1659x2212px; CFP
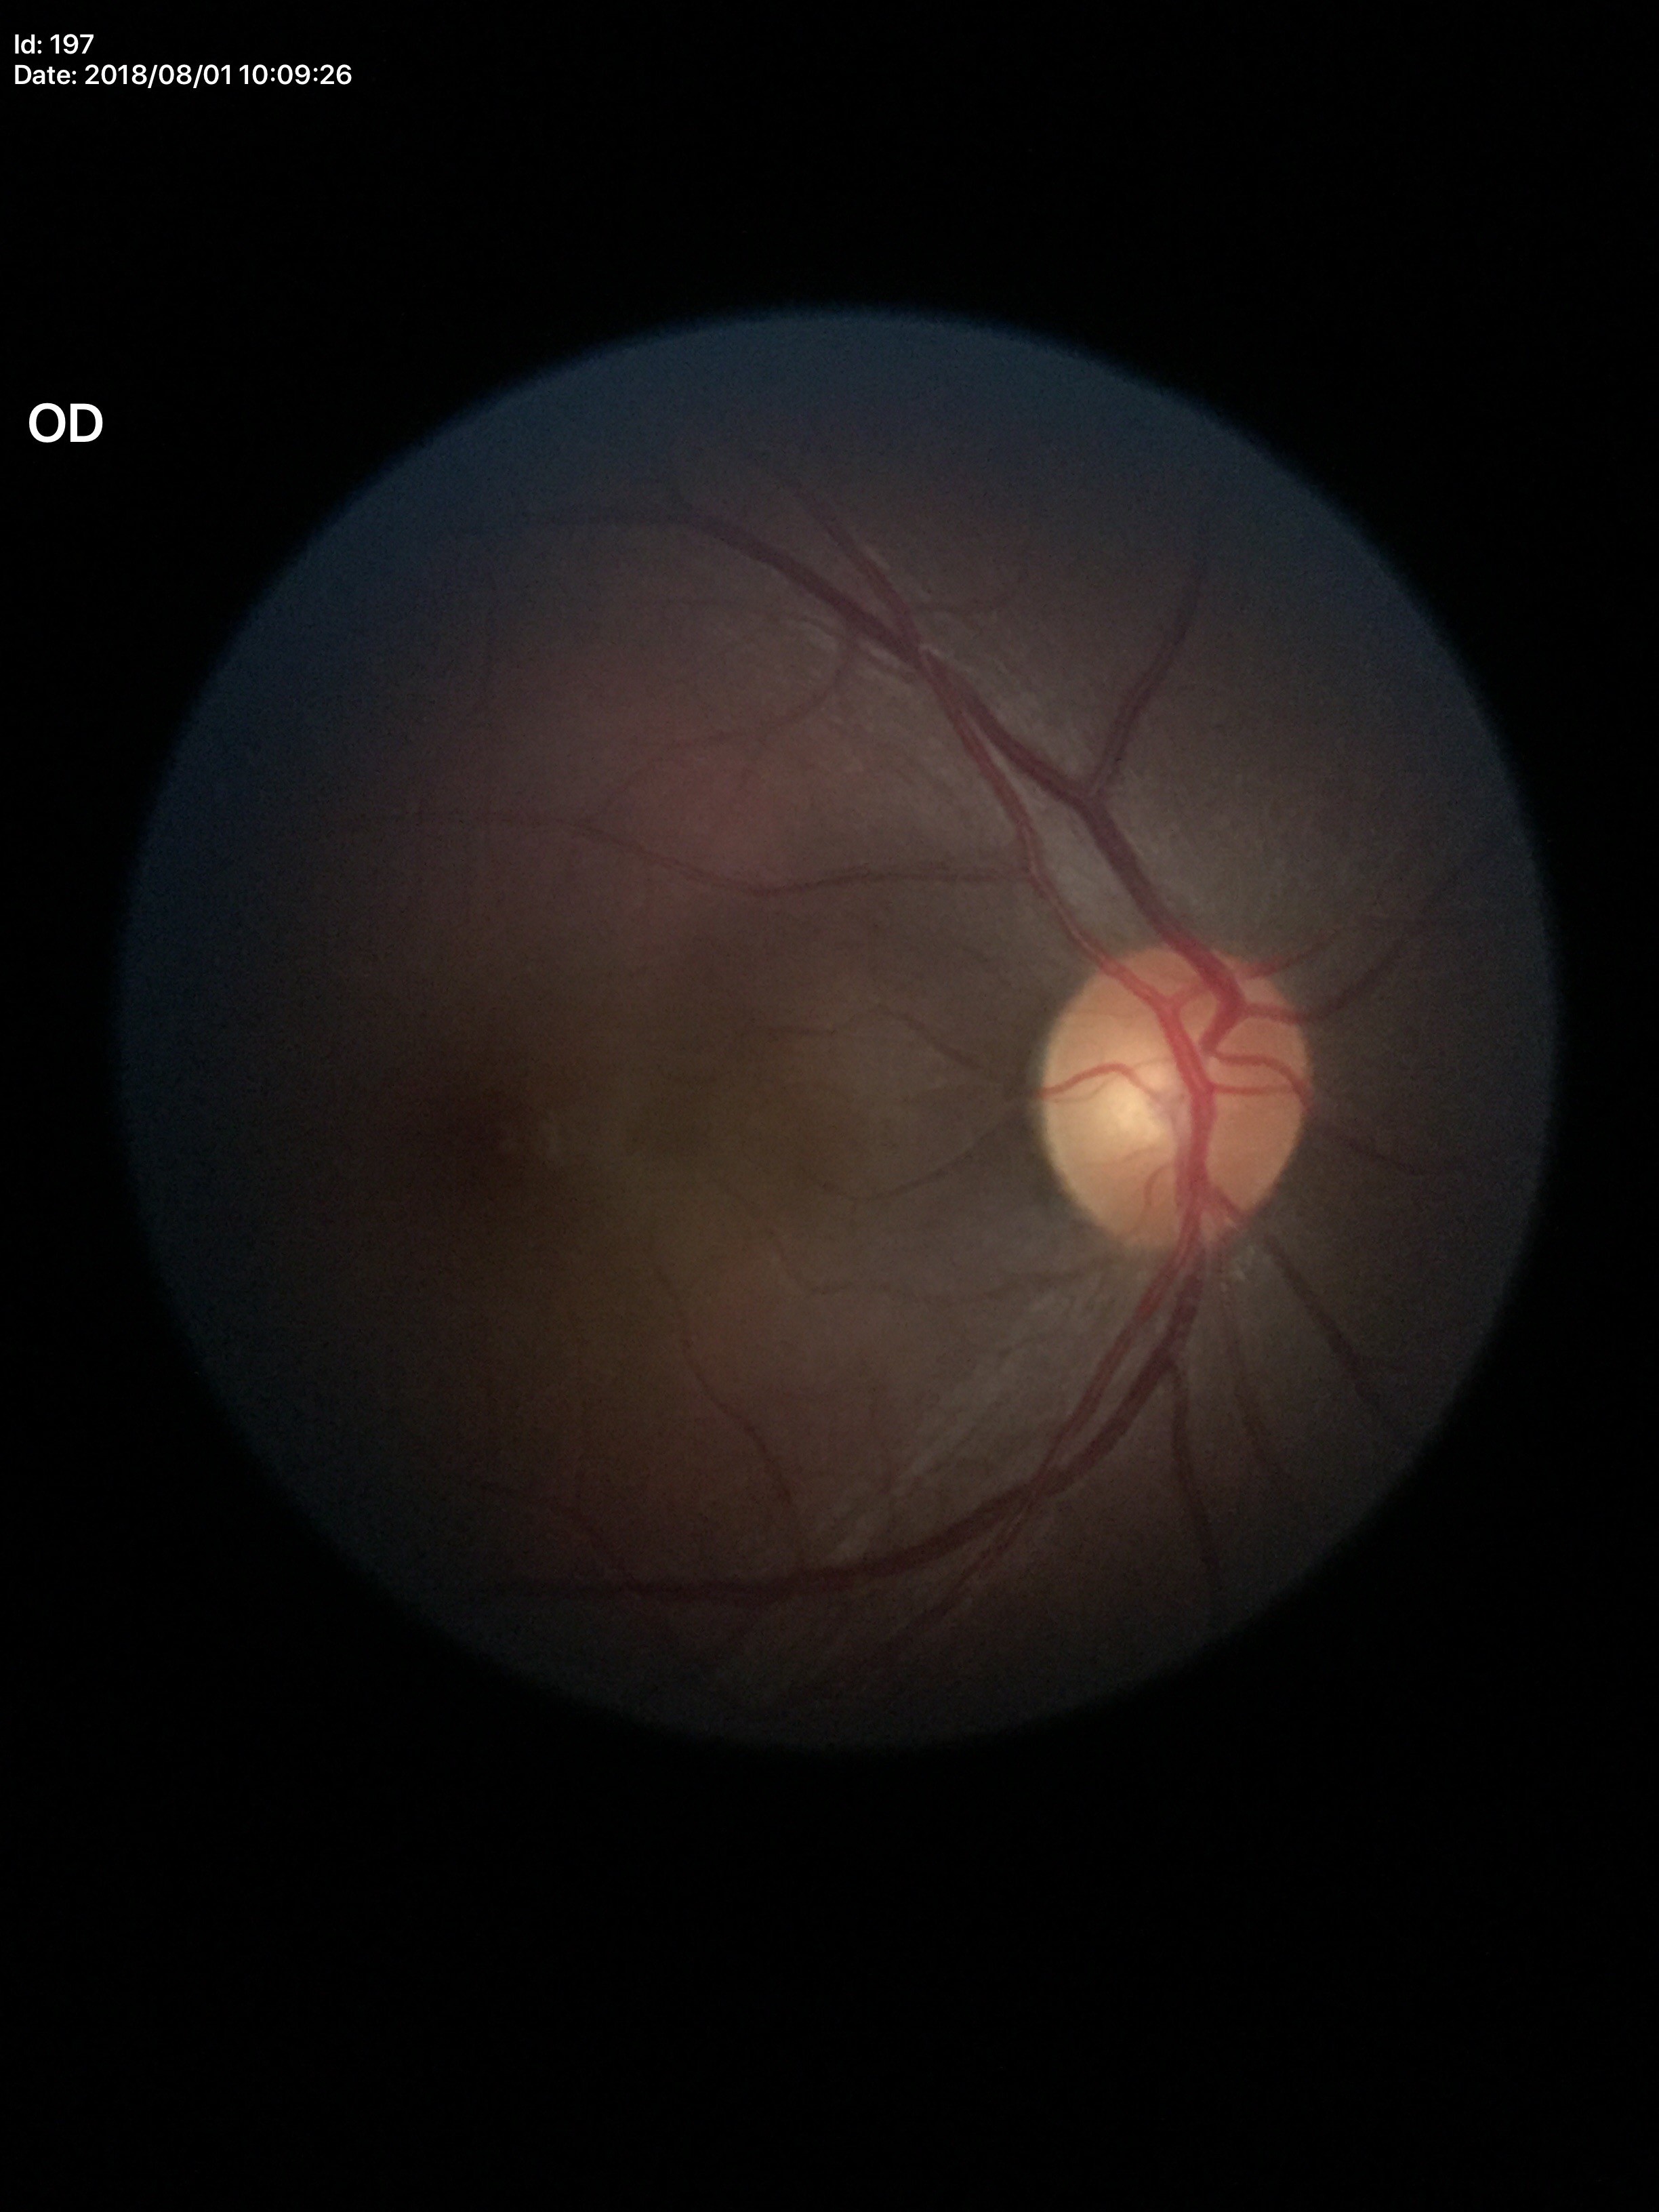 Not suspicious for glaucoma.
Vertical cup-to-disc ratio: 0.48.